RetCam wide-field infant fundus image. Camera: Natus RetCam Envision (130° FOV) — 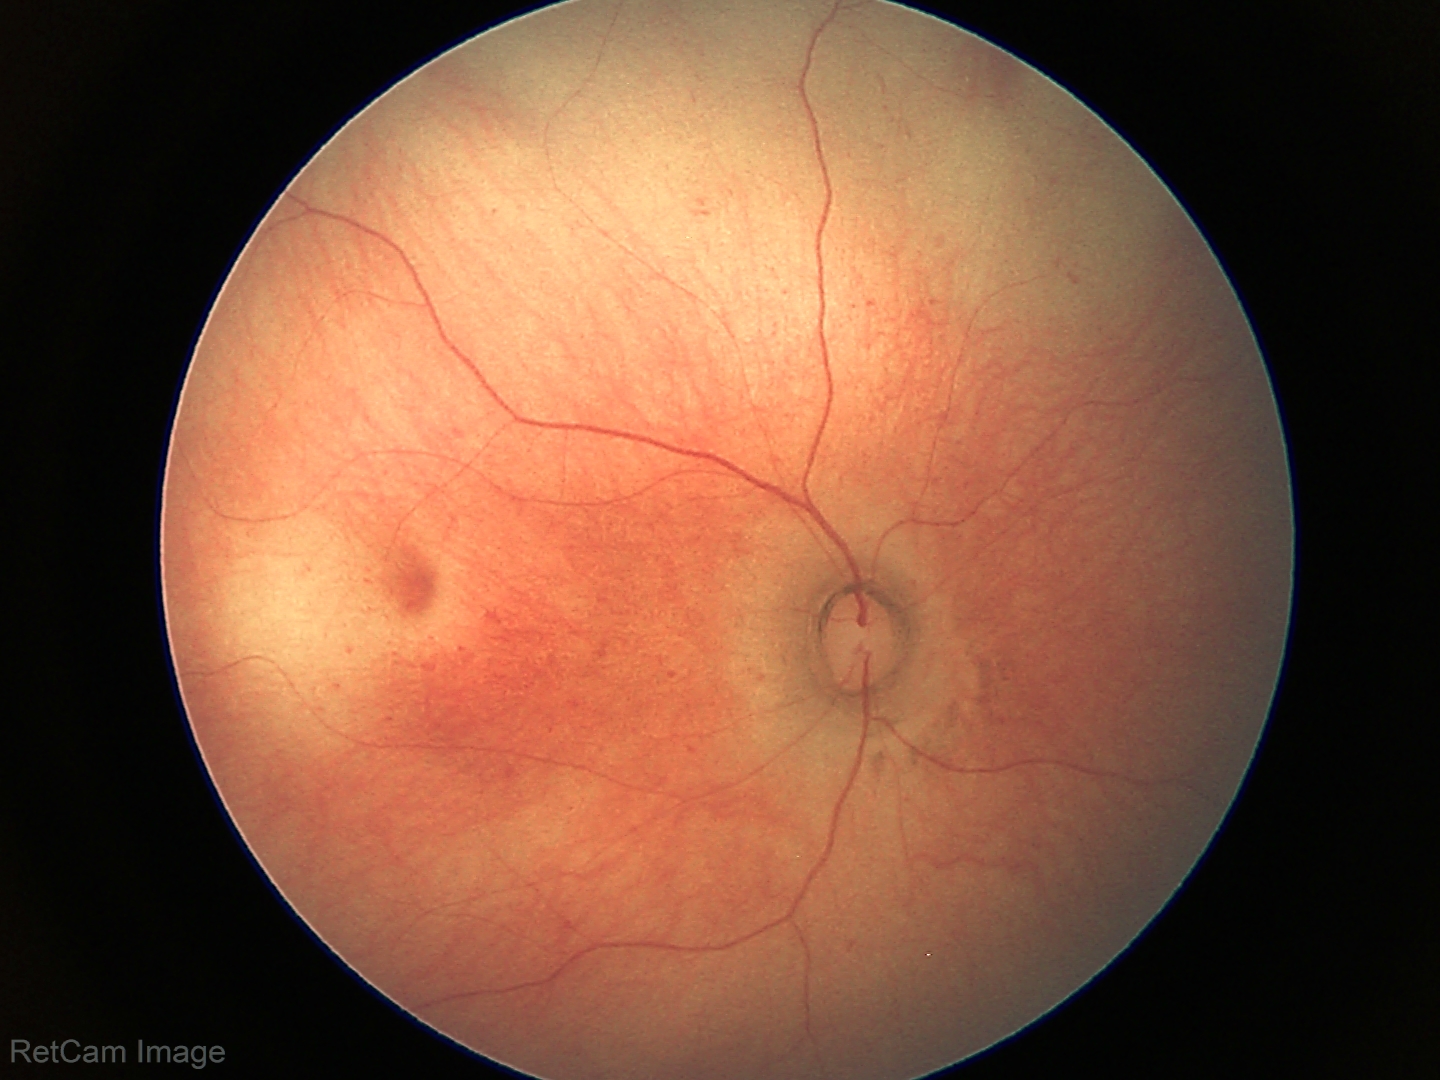

Screening examination diagnosed as physiological.